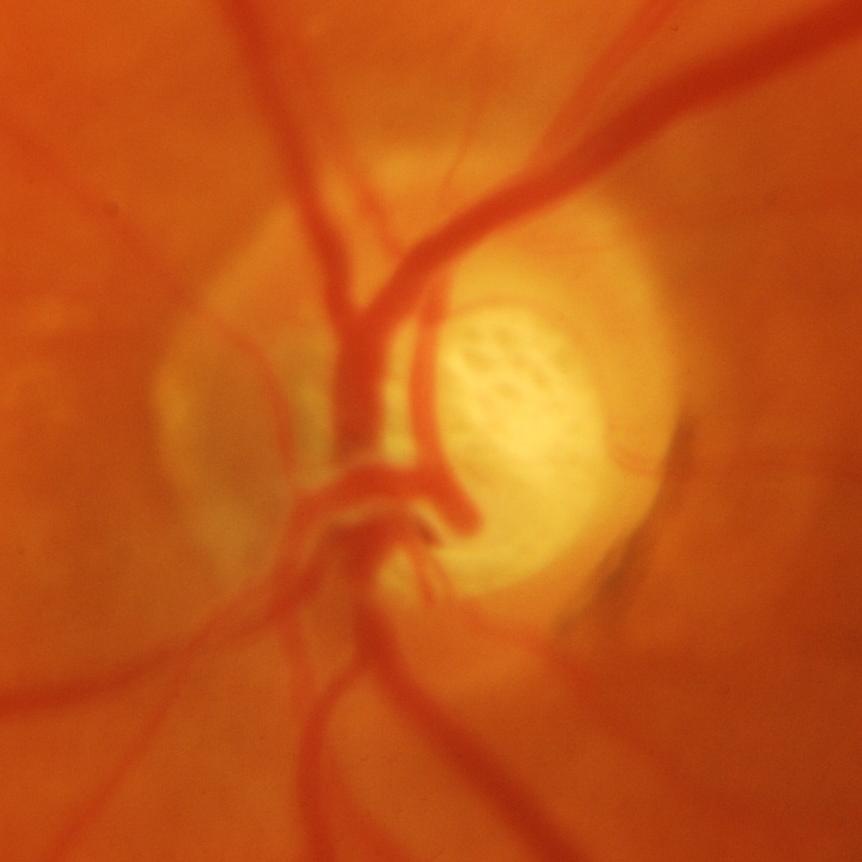
Optic nerve head appearance consistent with glaucomatous findings.